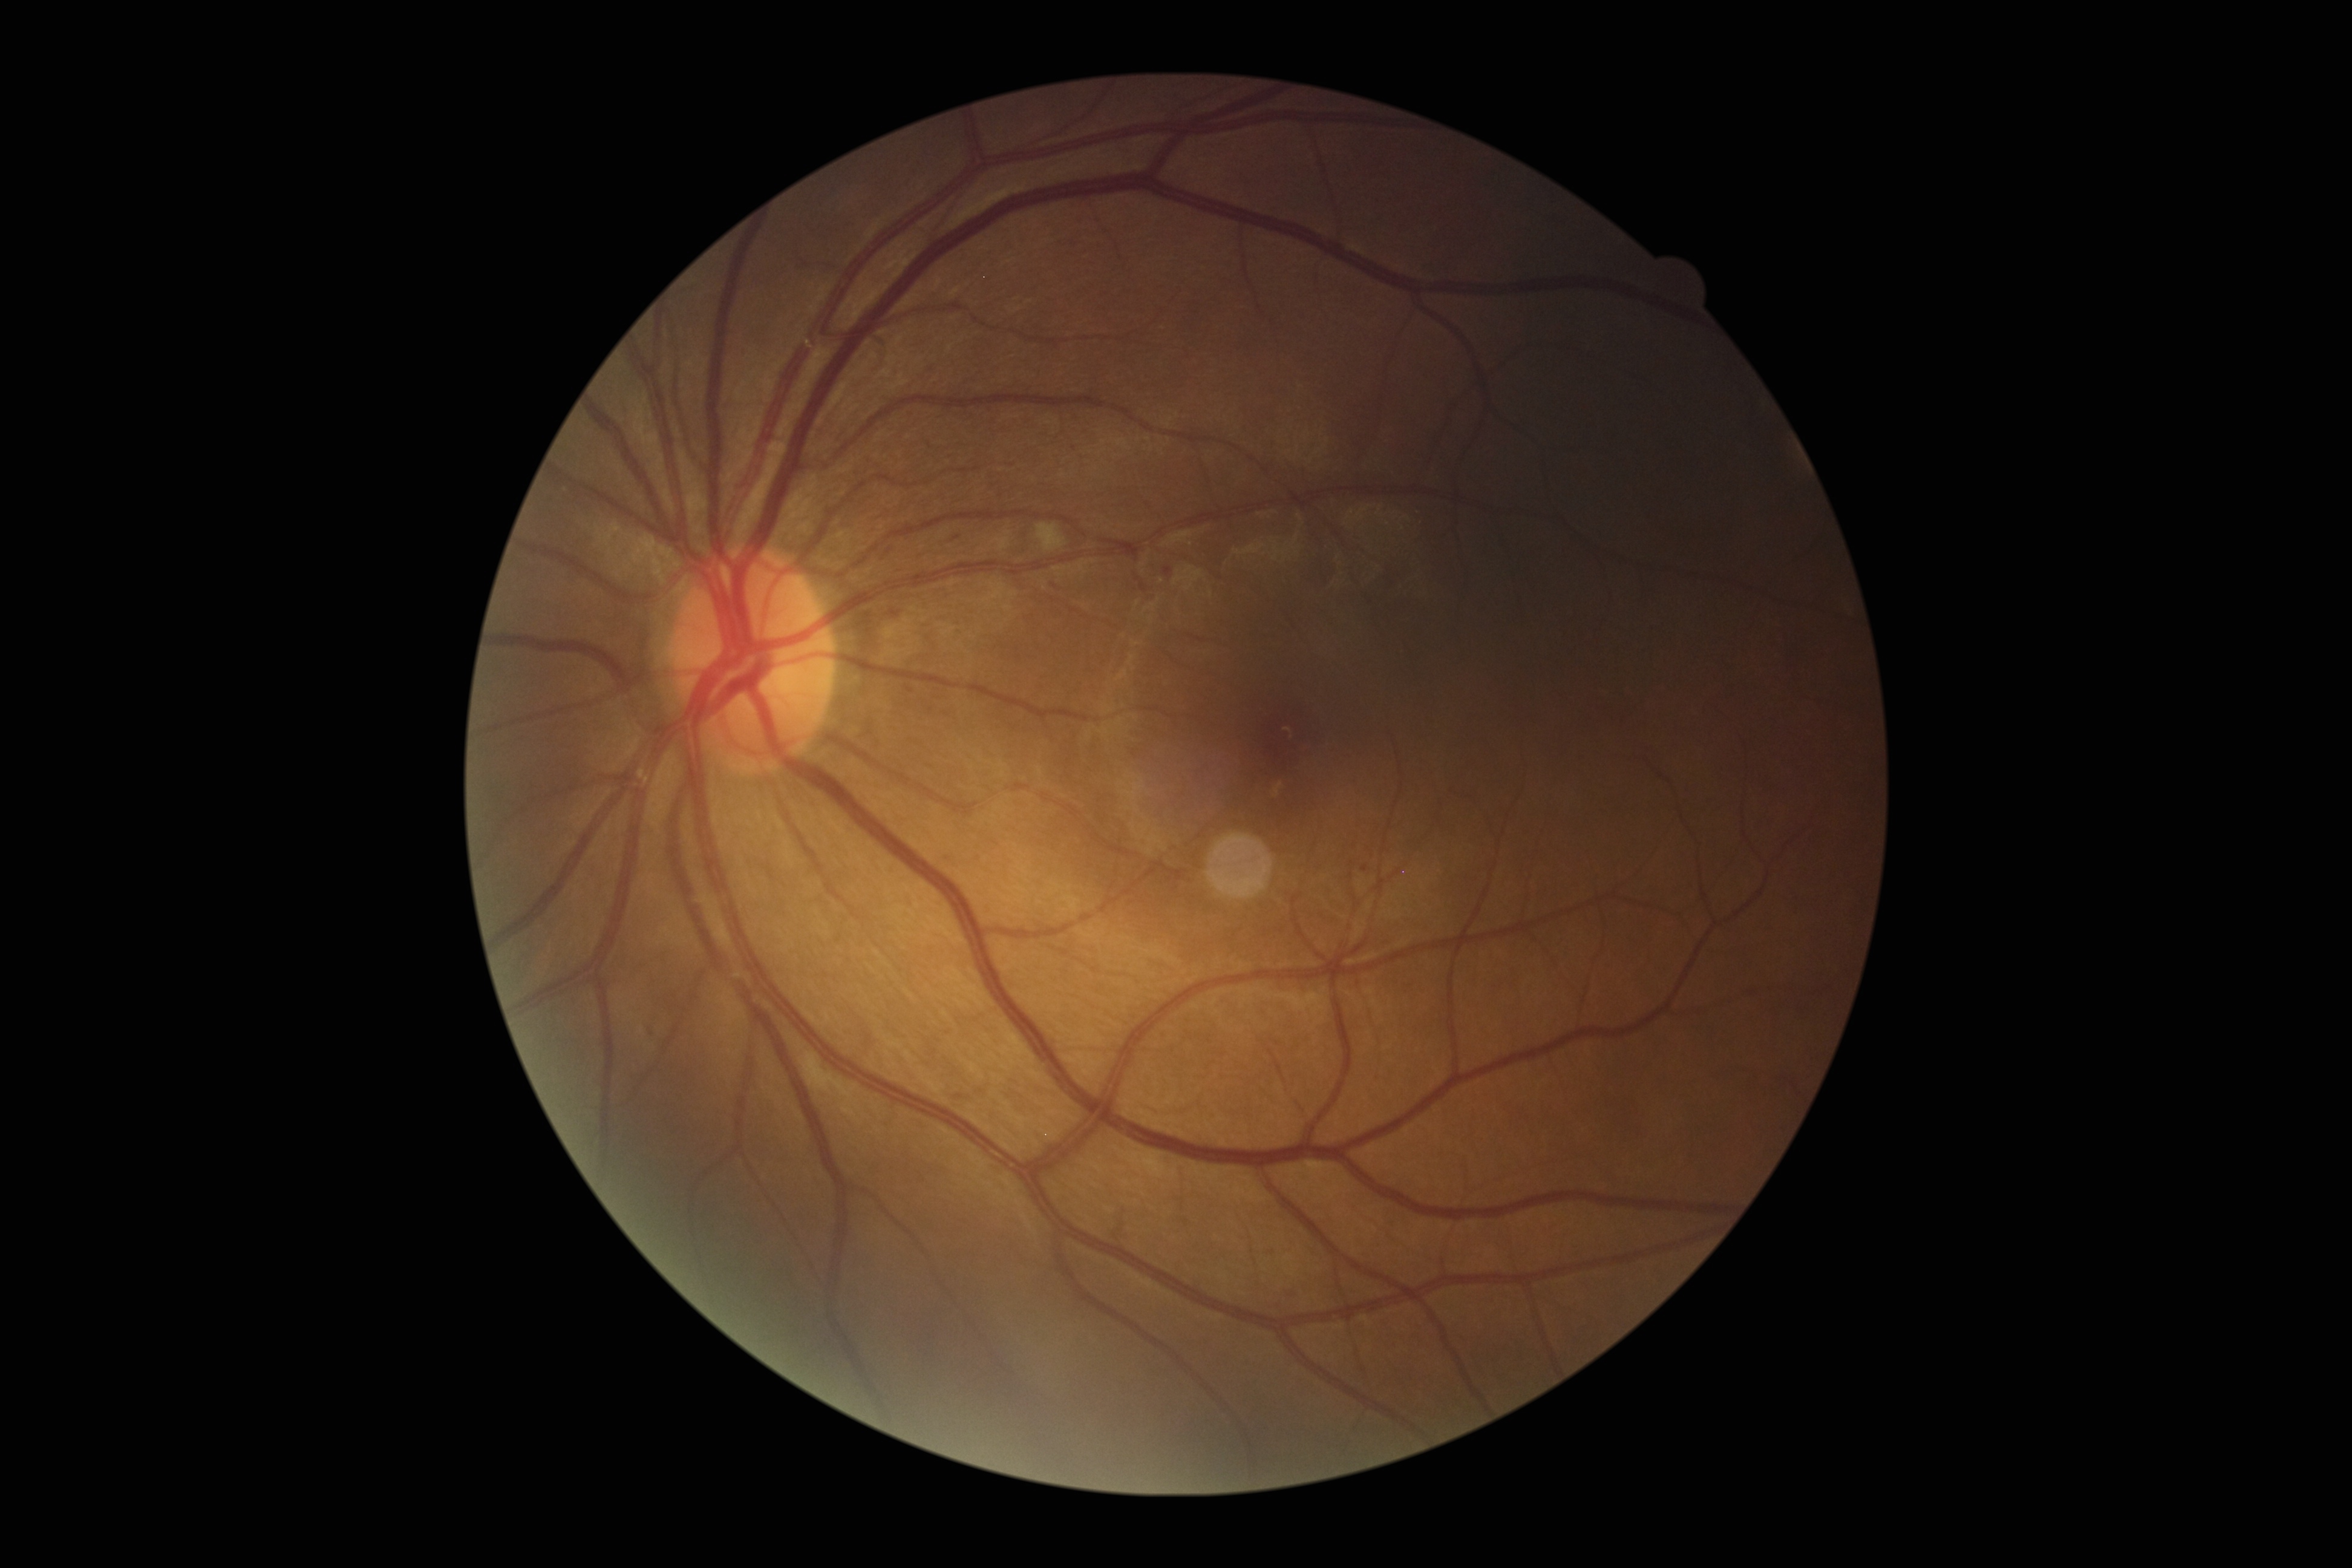

Annotations:
• DR class: non-proliferative diabetic retinopathy
• diabetic retinopathy: moderate NPDR (grade 2) — more than just microaneurysms but less than severe NPDR